Graded on the modified Davis scale; 848x848px; FOV: 45 degrees — 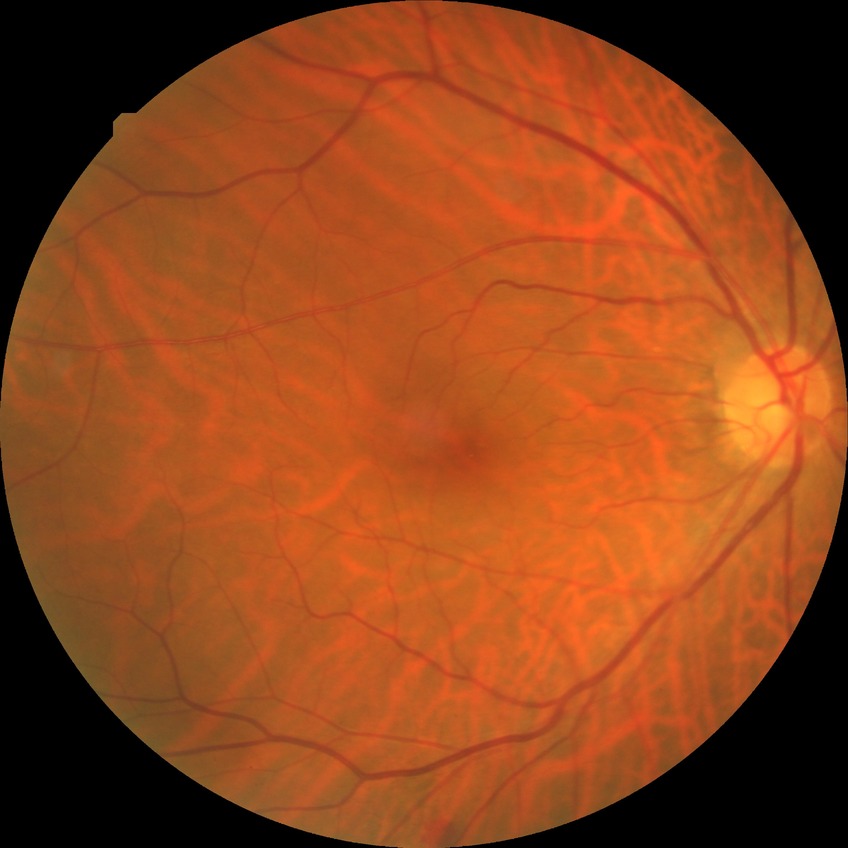
Annotations:
• modified Davis grading — no diabetic retinopathy